Camera: Topcon TRC. Fundus image cropped to the optic disc:
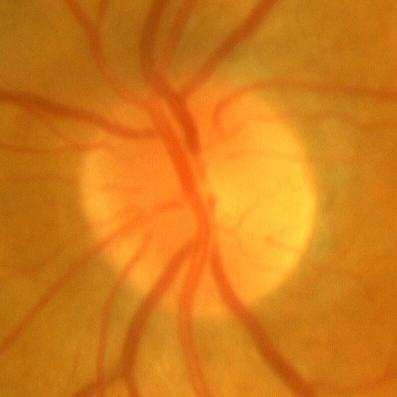
Findings consistent with no glaucoma.